Wide-field fundus image from infant ROP screening. Acquired on the Phoenix ICON:
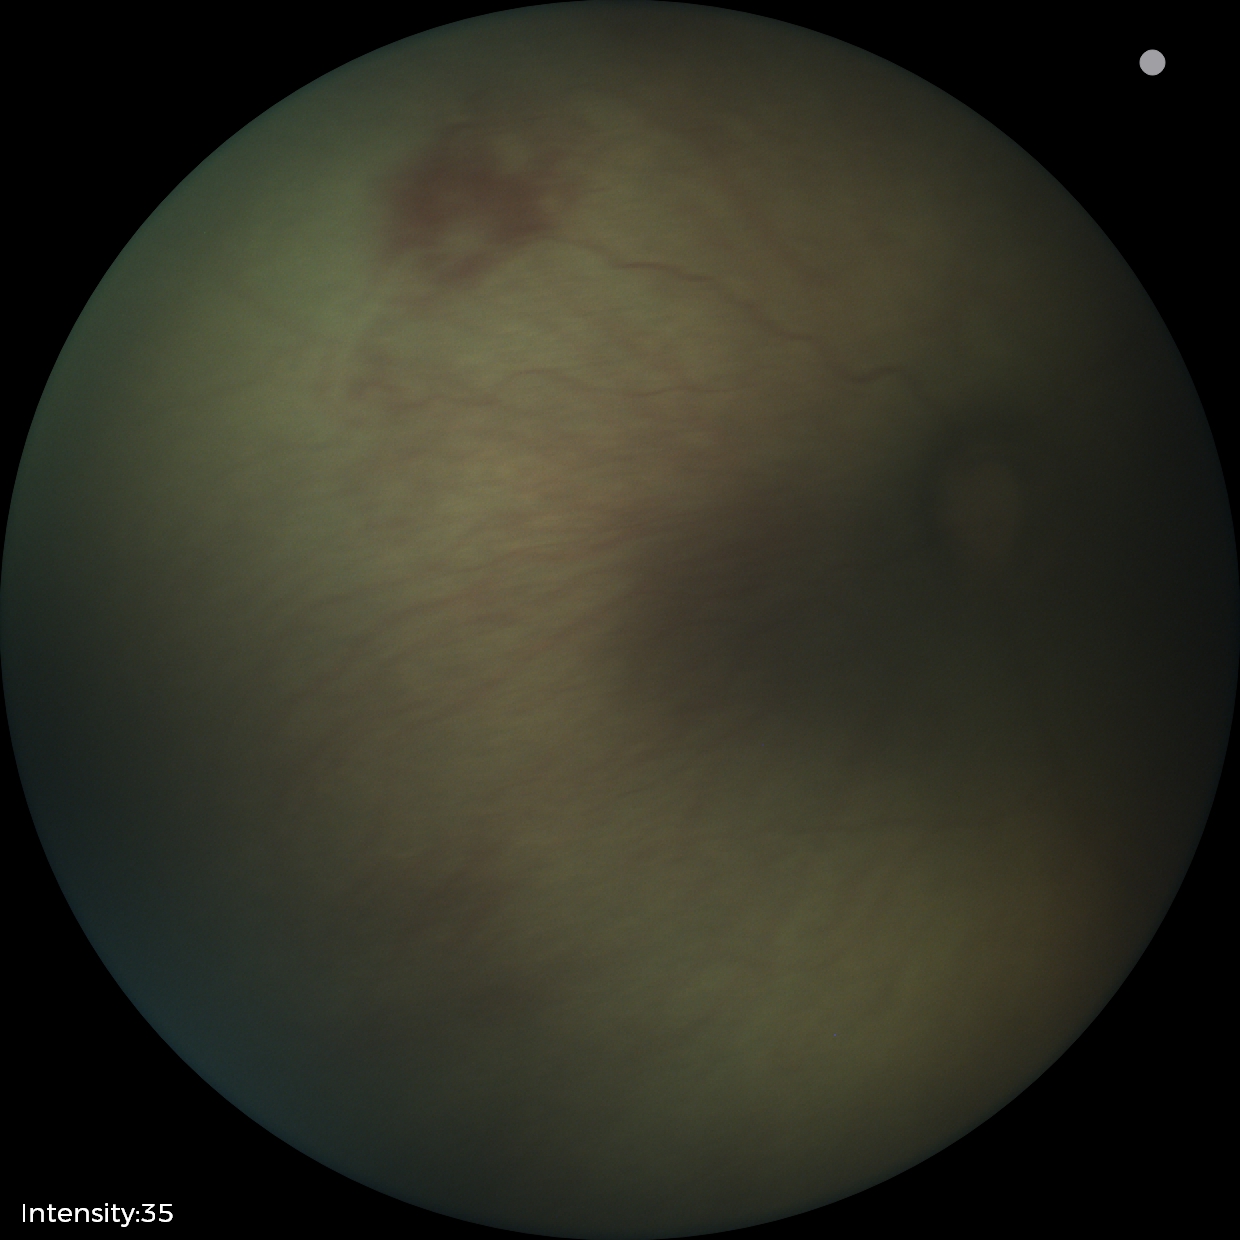 Examination diagnosed as retinopathy of prematurity stage 0 — incomplete retinal vascularization without a demarcation line. Without plus disease.